Without pupil dilation. 45° field of view.
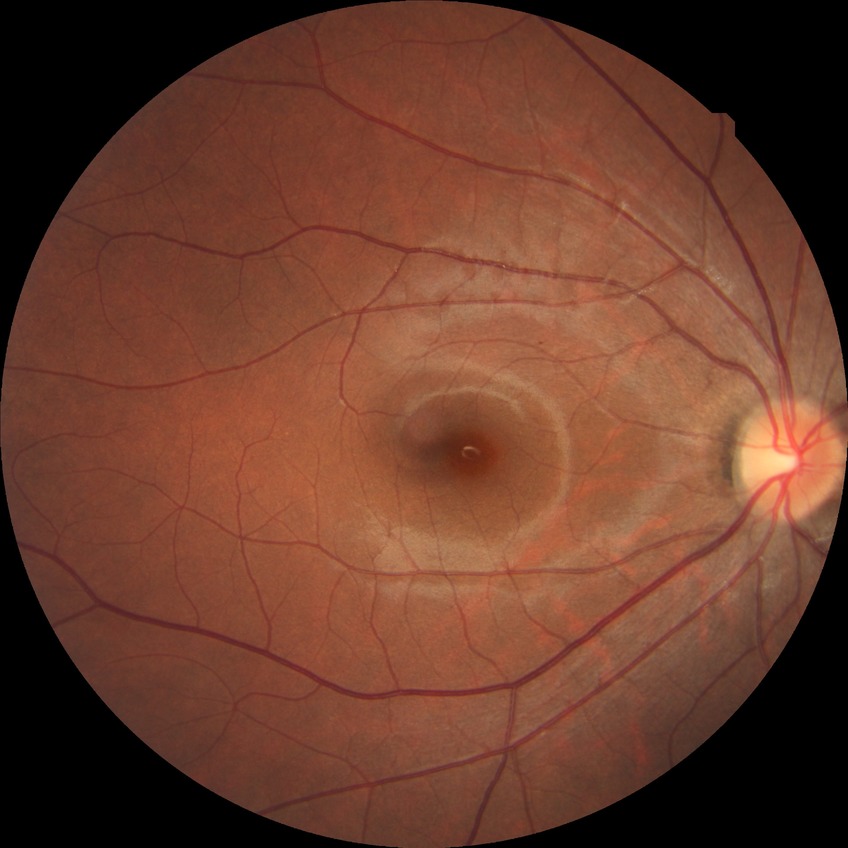

diabetic retinopathy grade: no diabetic retinopathy.